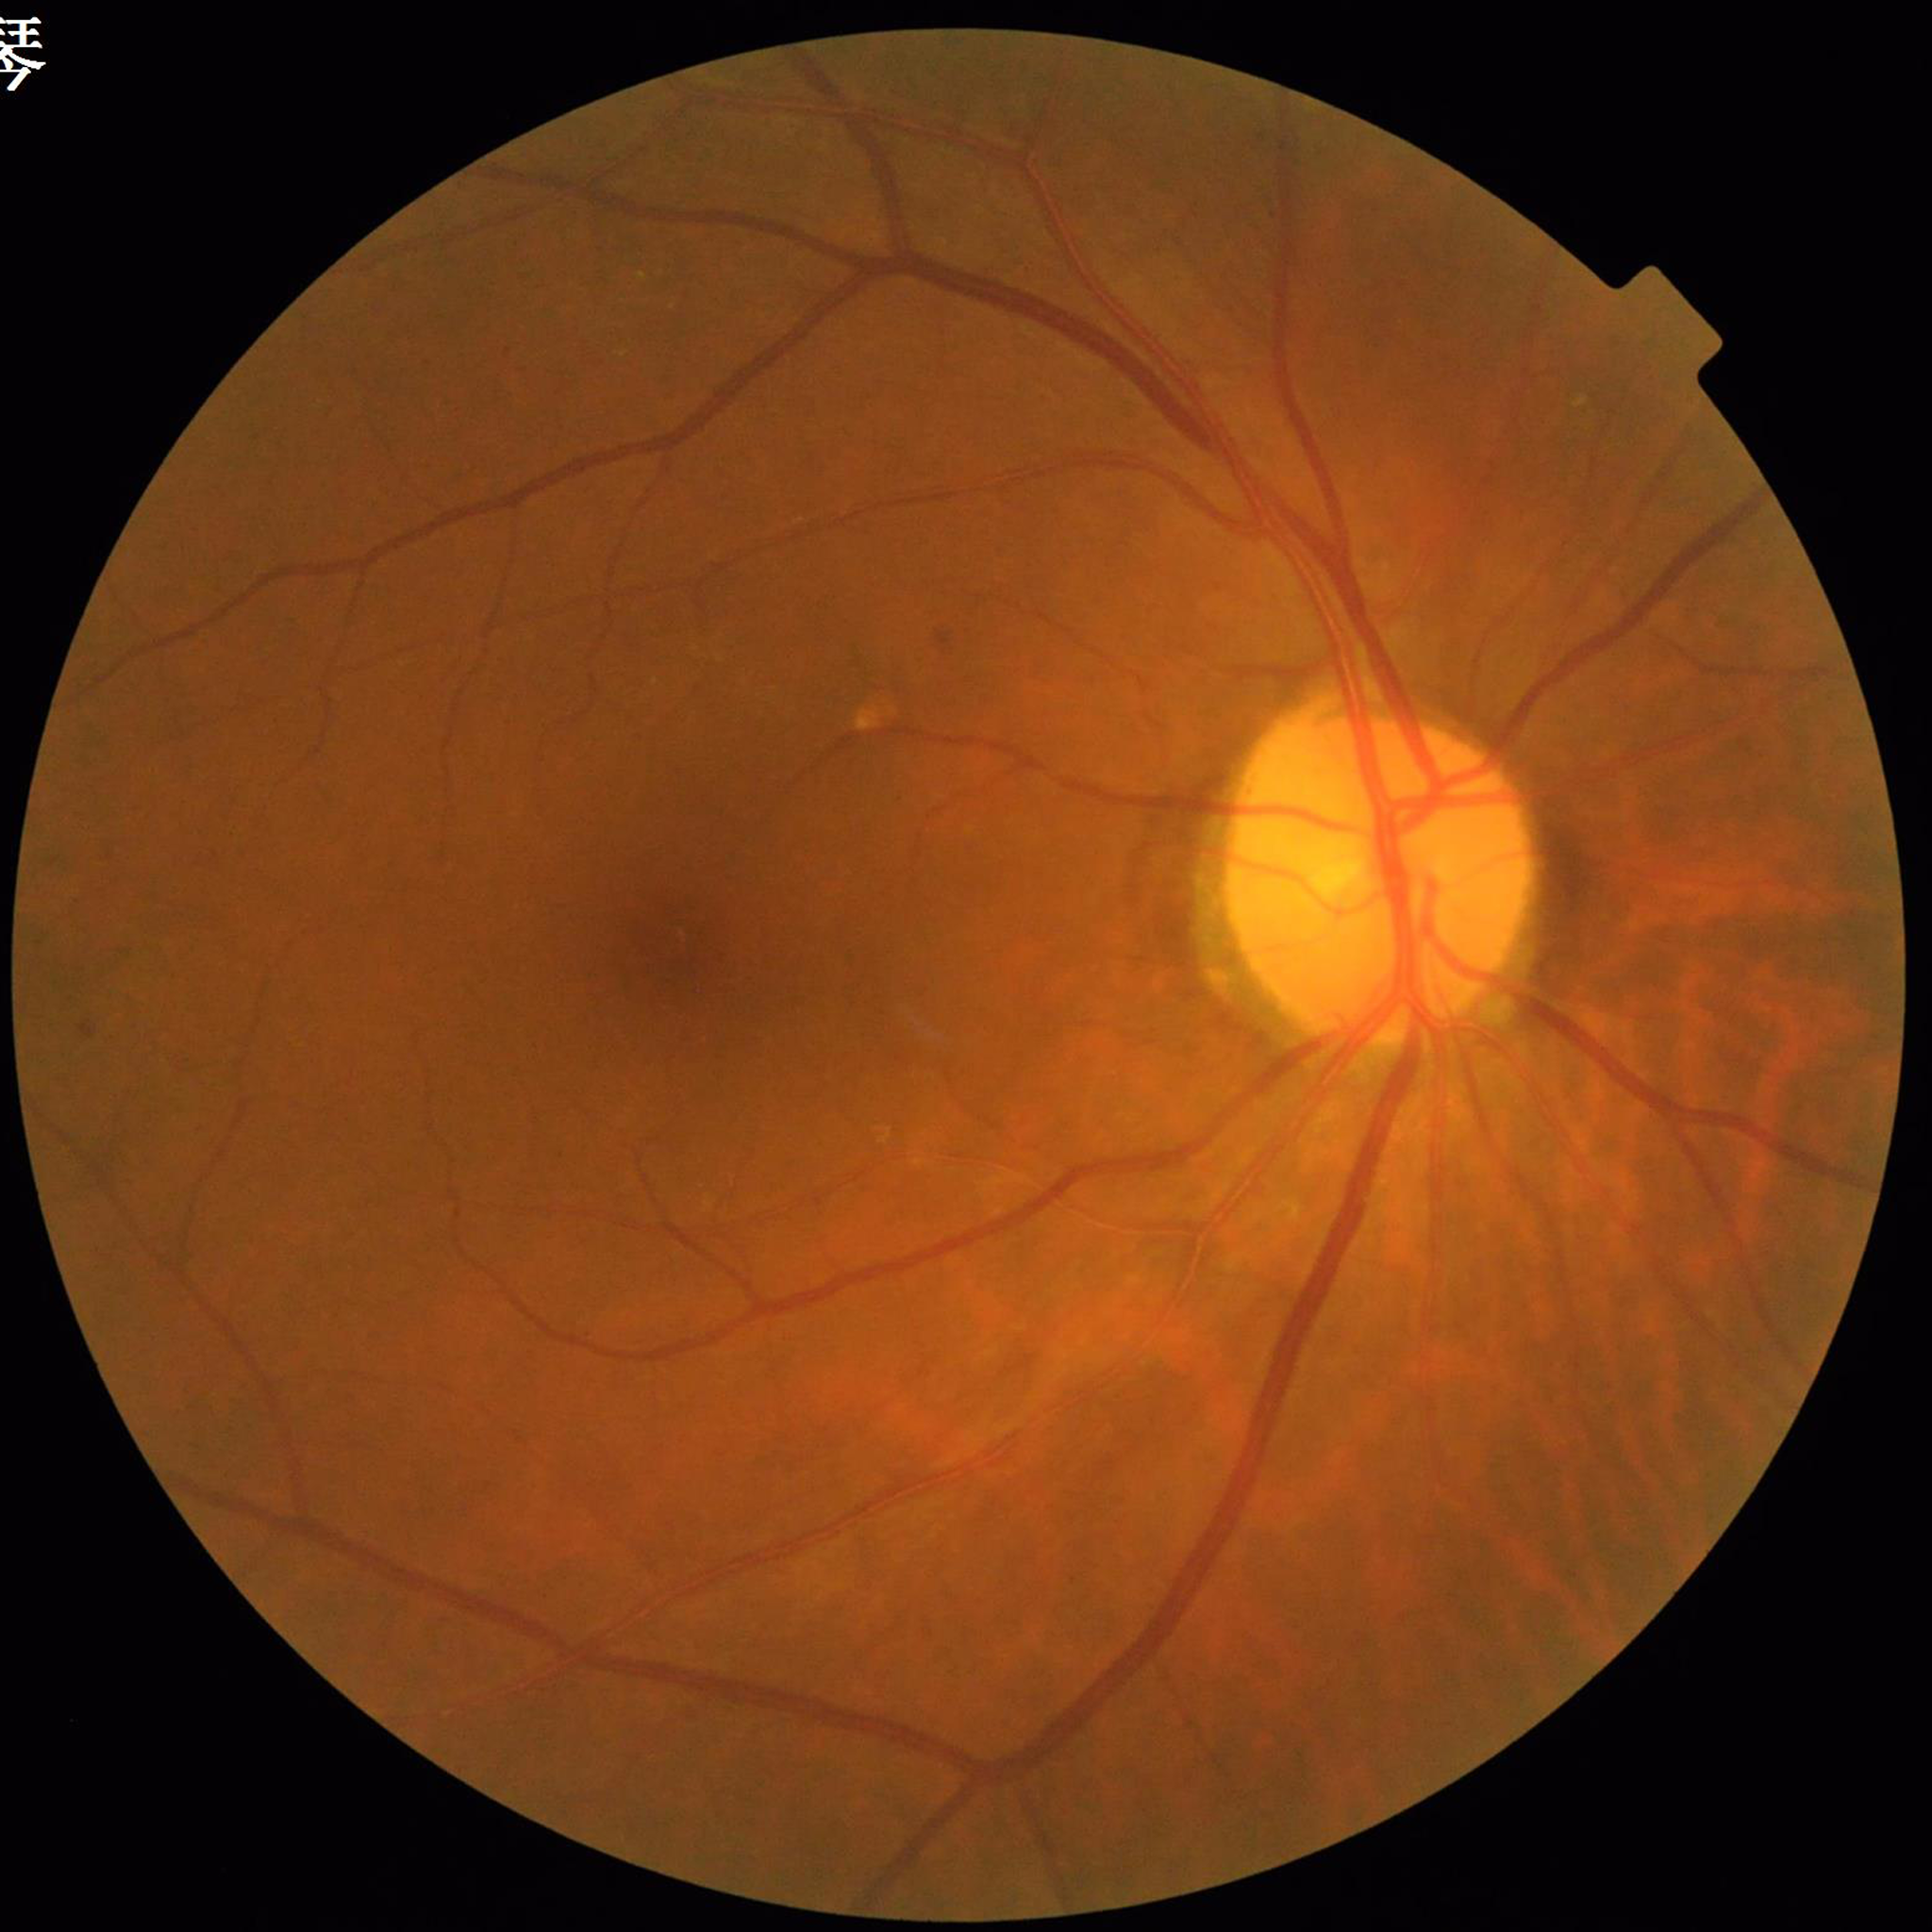 diagnosis: diabetic retinopathy (DR)